Color fundus image. 2352 x 1568 pixels
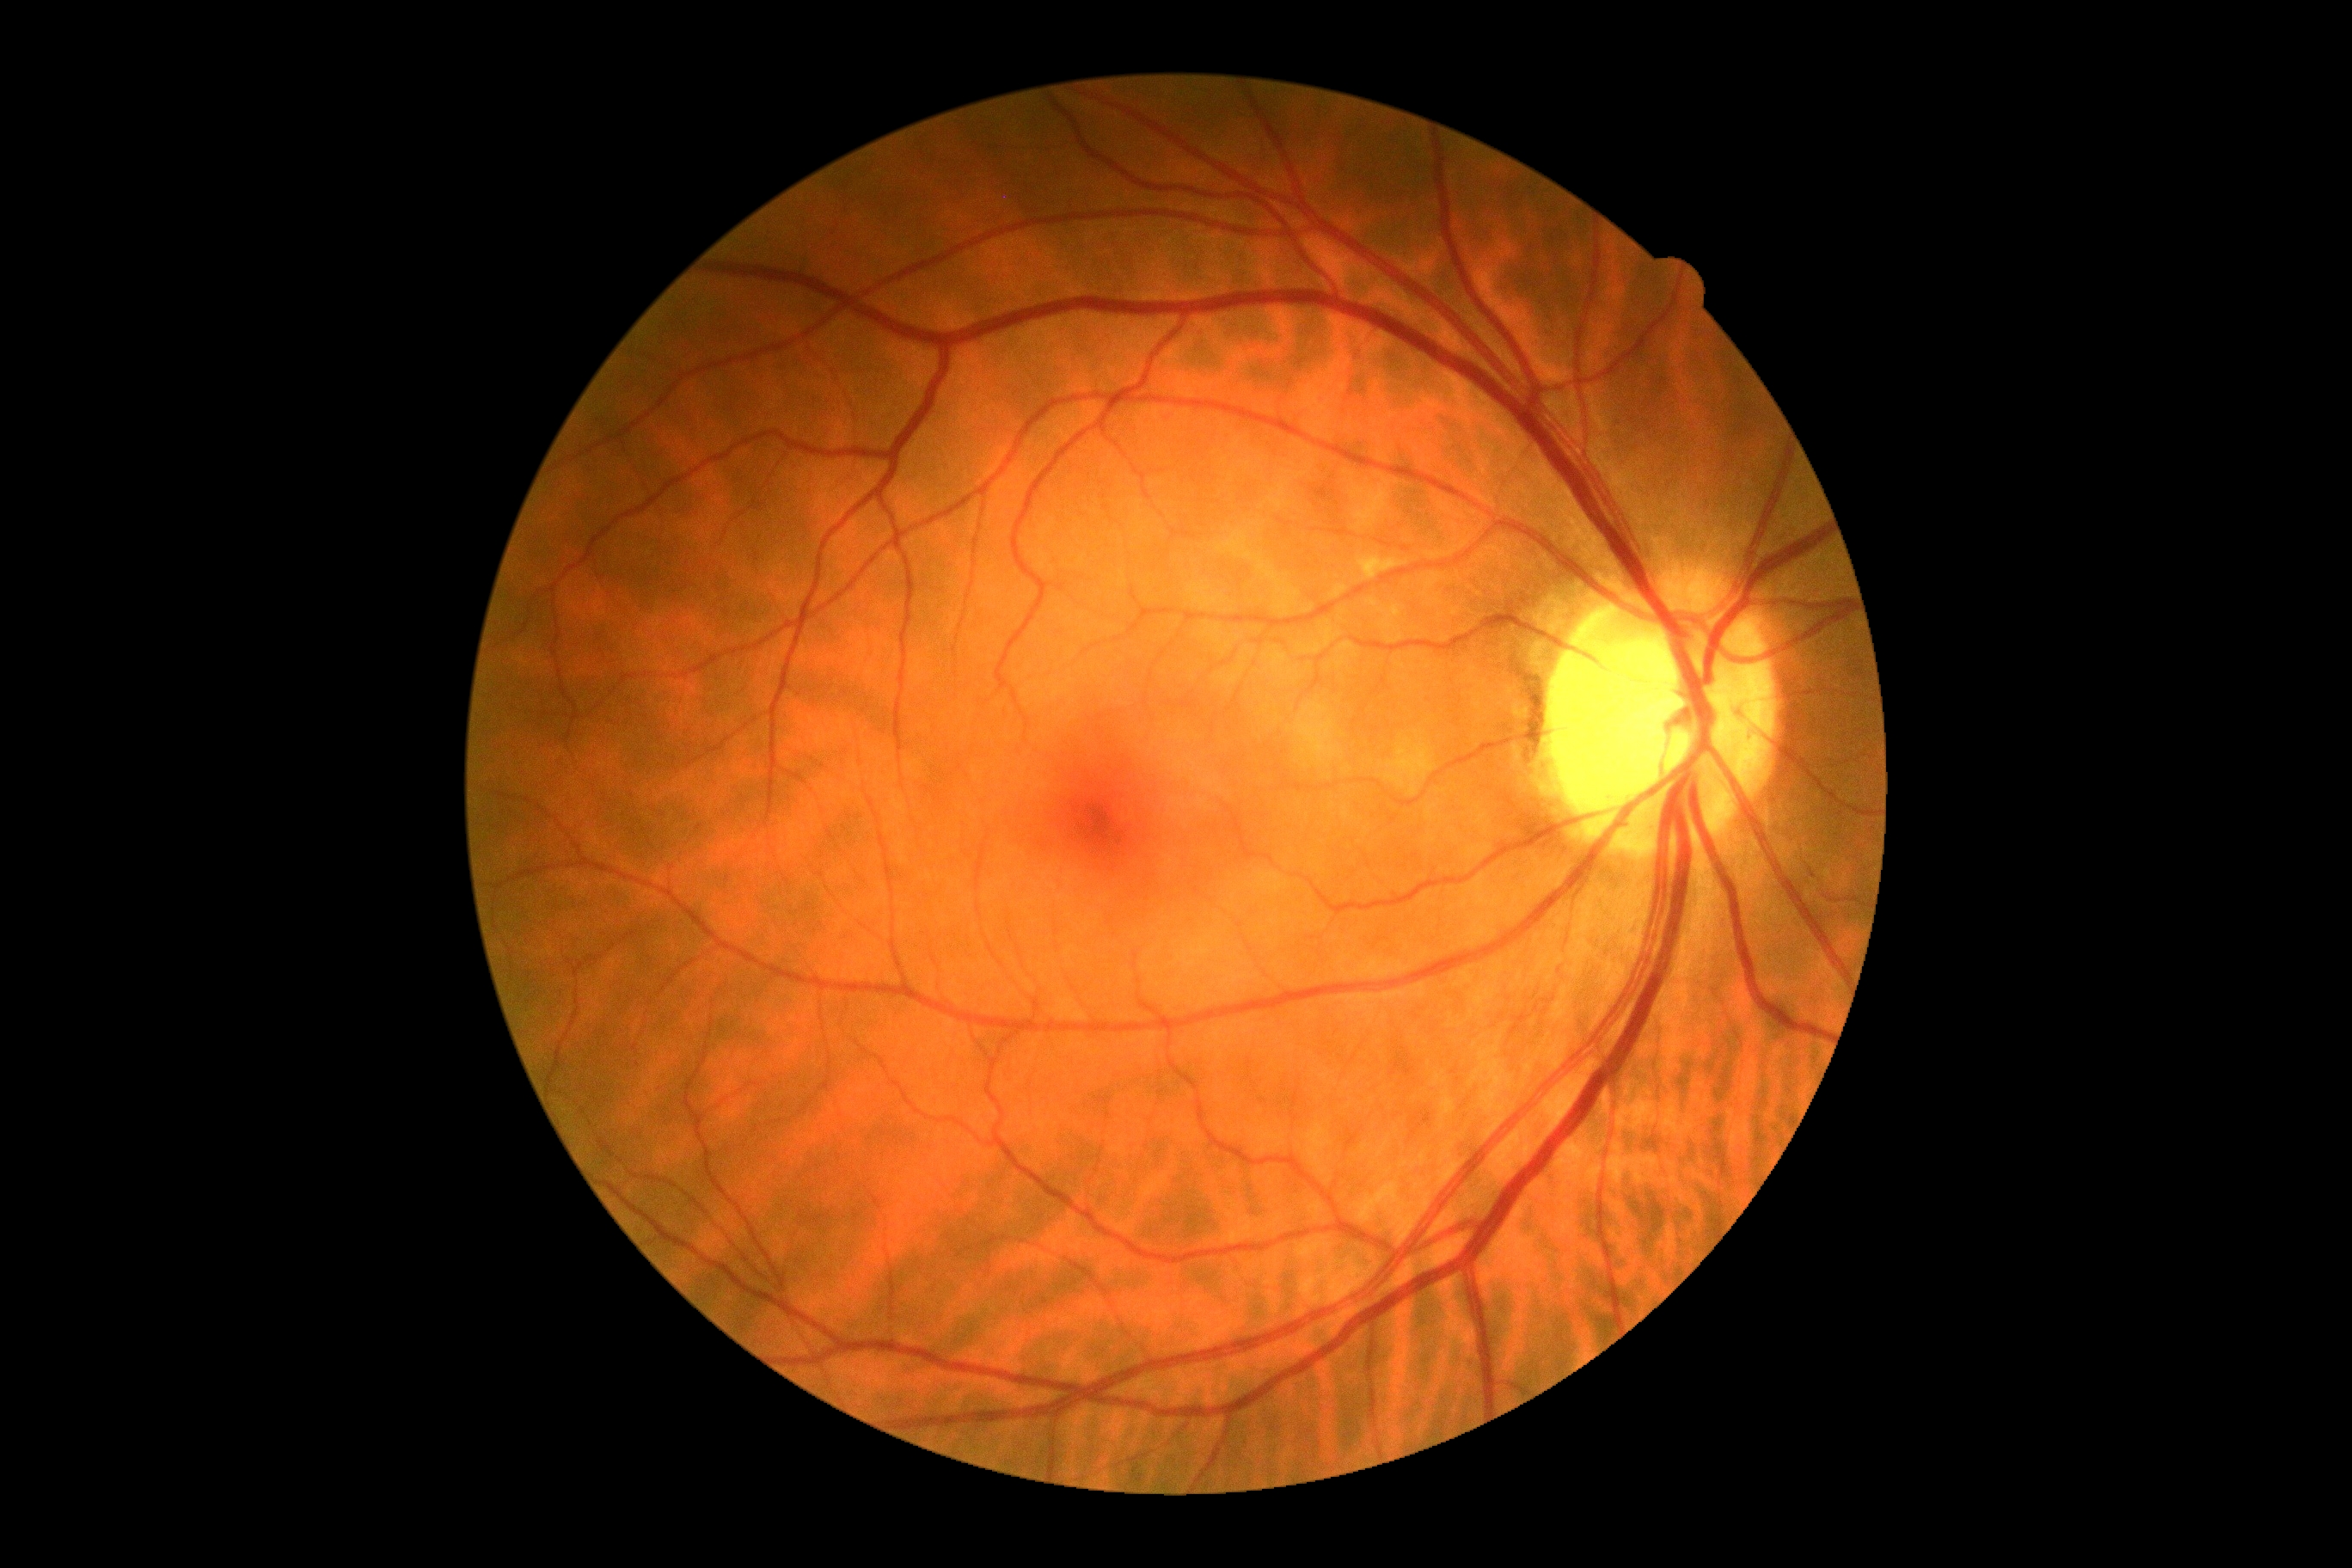 Diabetic retinopathy (DR): no apparent retinopathy (grade 0).